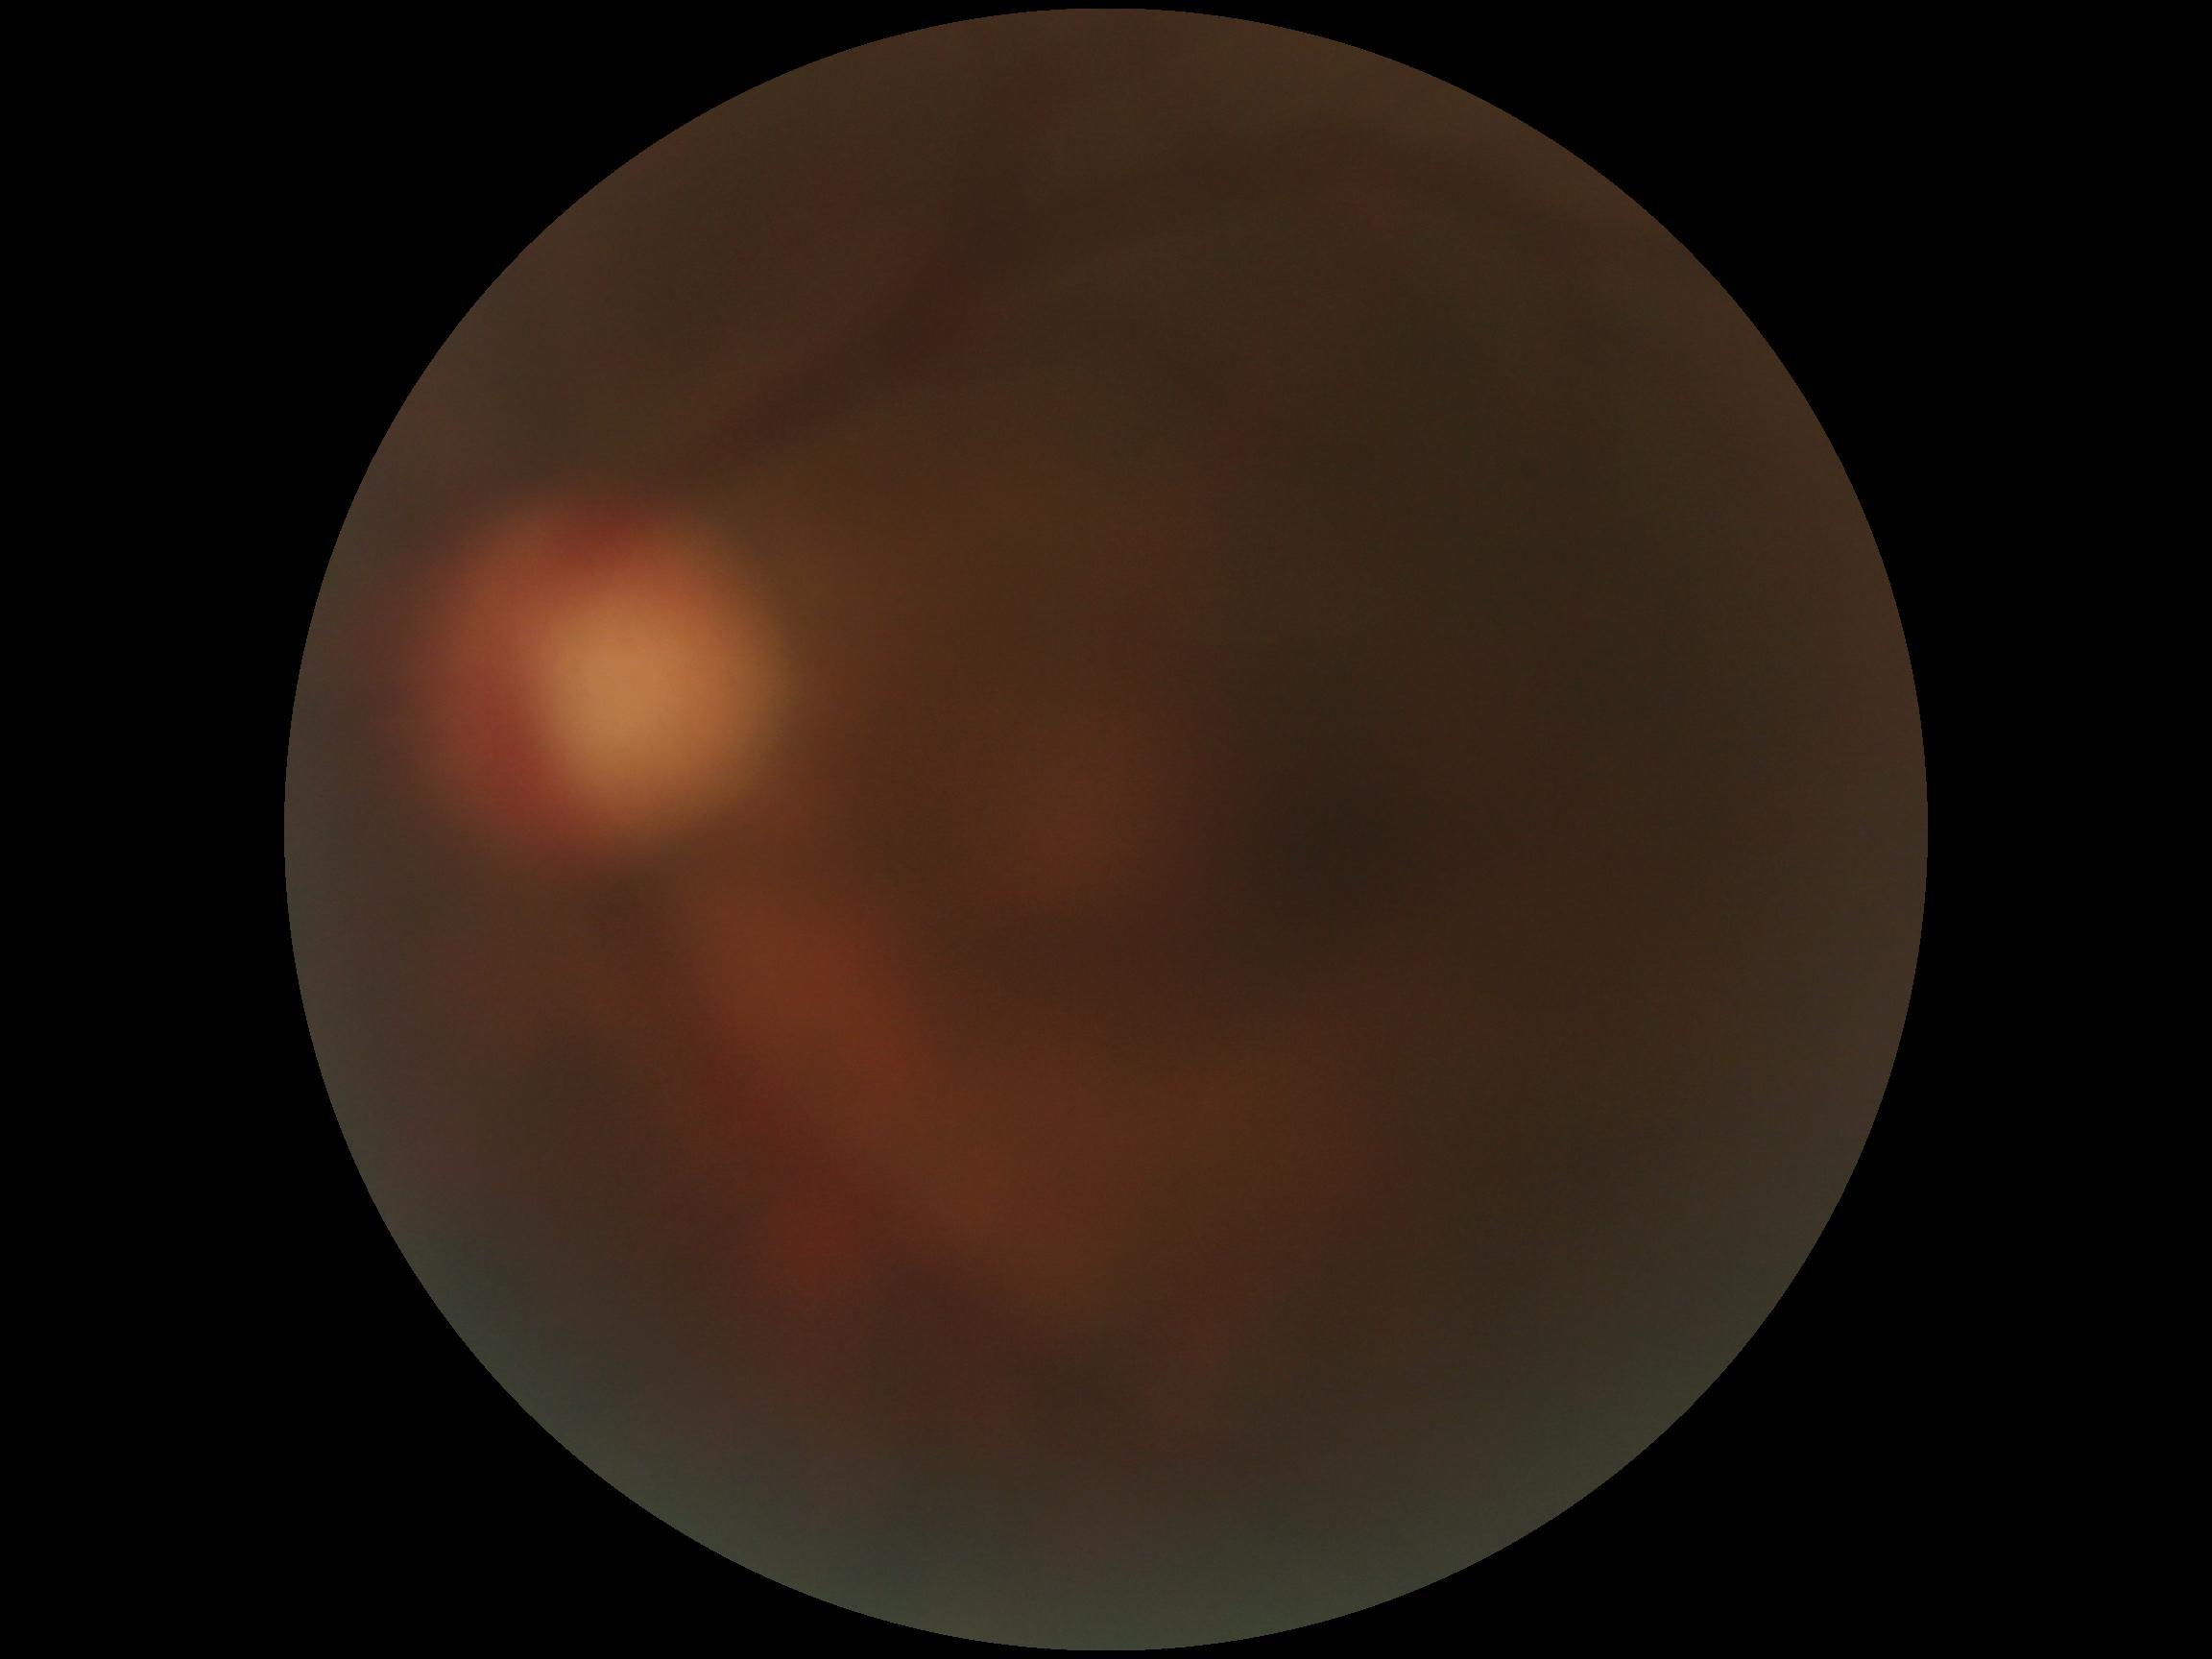
DR grade is ungradable.